Image size 848x848, DR severity per modified Davis staging
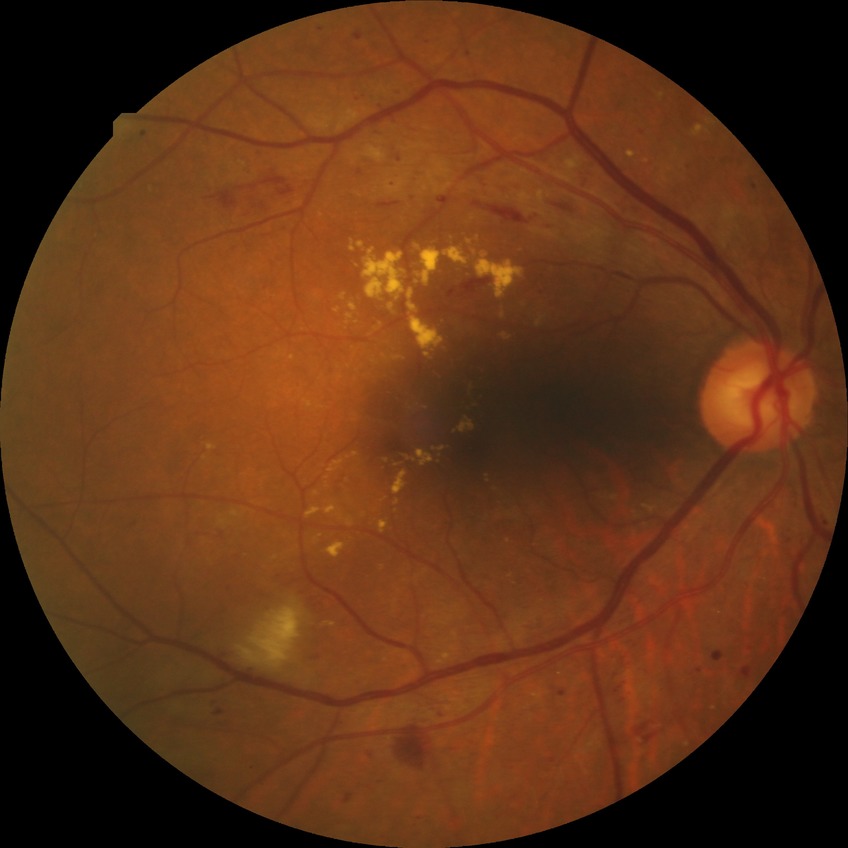 The retinopathy is classified as non-proliferative diabetic retinopathy. Diabetic retinopathy (DR) is PPDR (pre-proliferative diabetic retinopathy).